1659x2212: 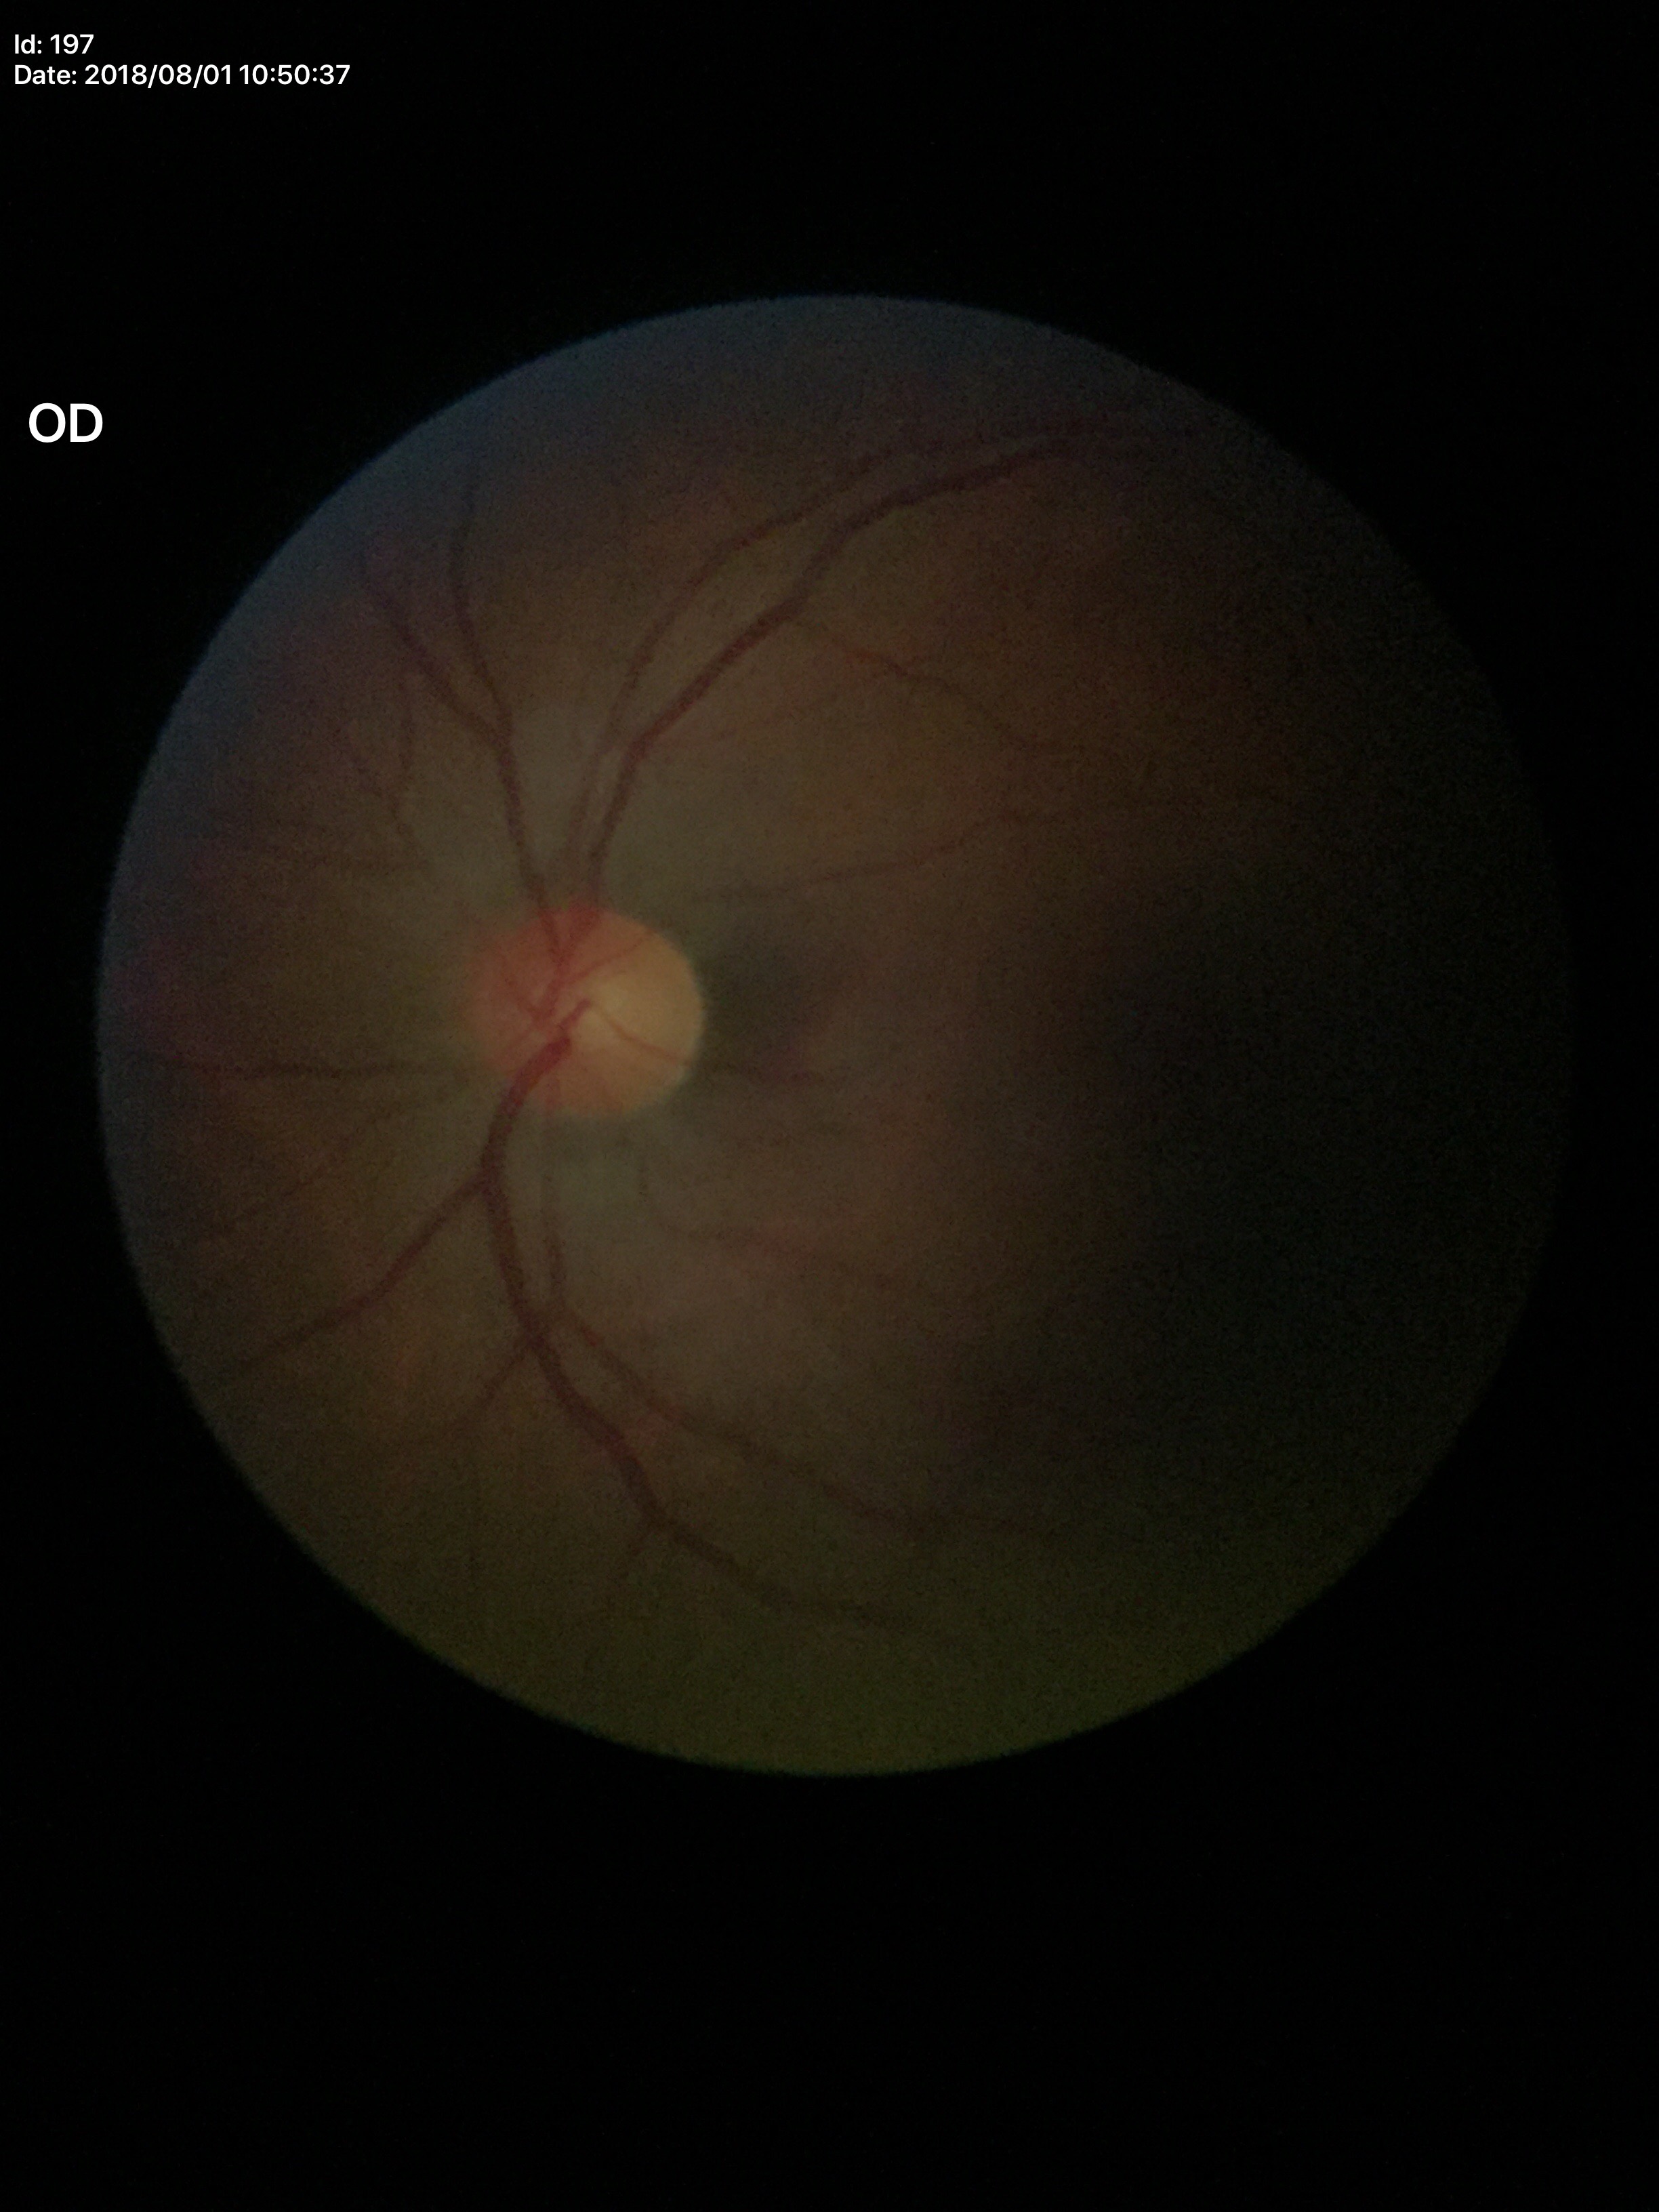
Q: Is there glaucoma suspicion?
A: no suspicious findings
Q: What is the VCDR?
A: 0.46
Q: What is the HCDR?
A: 0.51